Image size 240x240. CFP
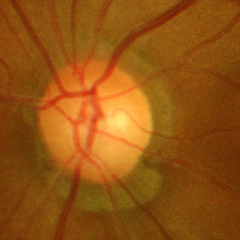
Glaucoma assessment = advanced glaucoma.